Wide-field fundus image from infant ROP screening: 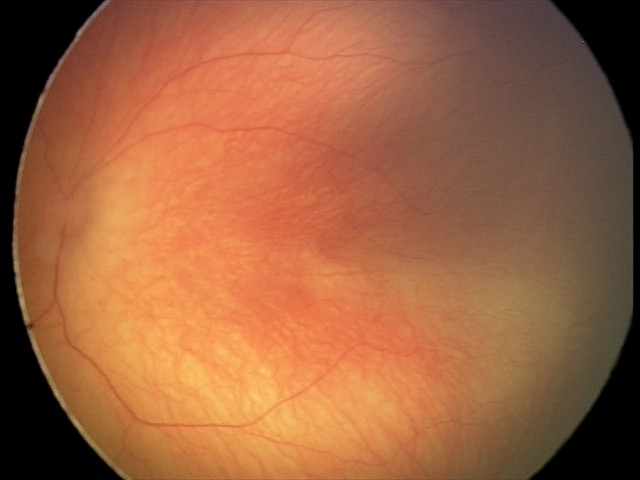 Series diagnosed as retinopathy of prematurity stage 0. Plus disease absent.